Without pupil dilation · acquired with a NIDEK AFC-230.
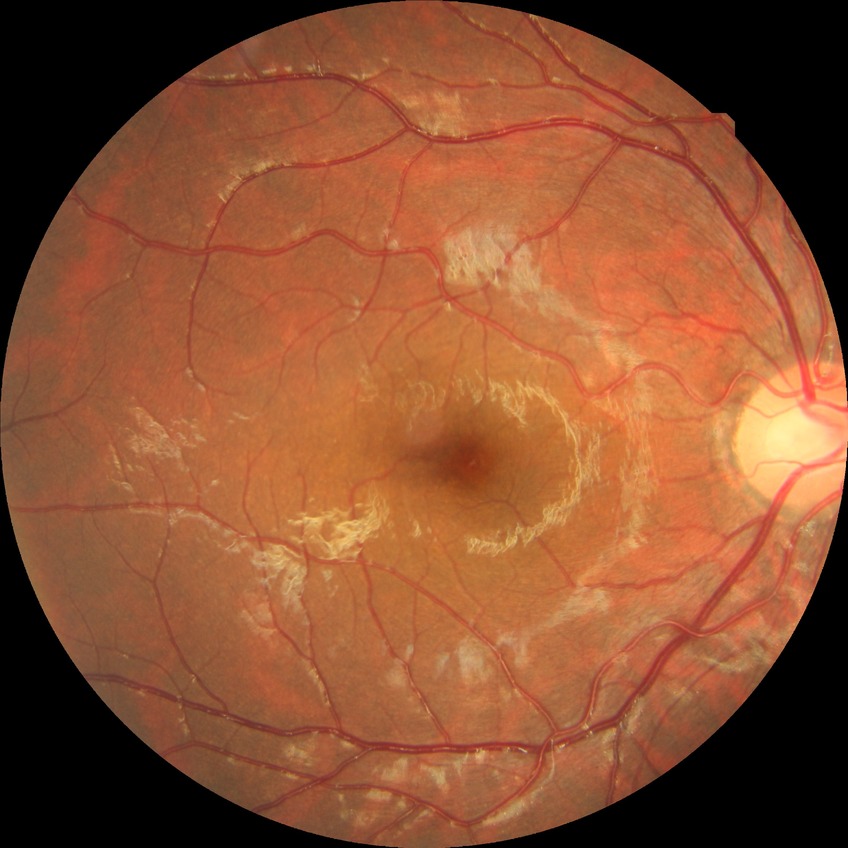

diabetic retinopathy (DR): NDR (no diabetic retinopathy).